Non-mydriatic acquisition:
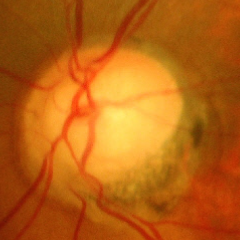
Showing advanced glaucomatous optic neuropathy. Diagnostic criteria: near-total cupping of the optic nerve head, with or without severe visual field loss within the central 10 degrees of fixation.